Without pupil dilation. 848 by 848 pixels.
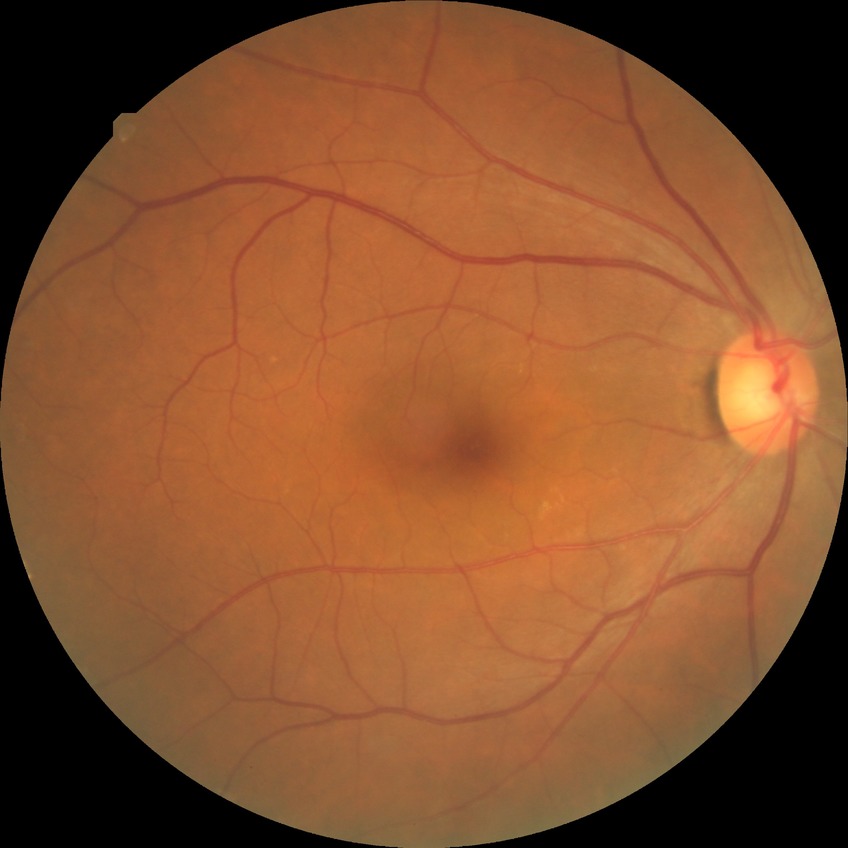

{
  "davis_grade": "NDR"
}